Infant wide-field retinal image.
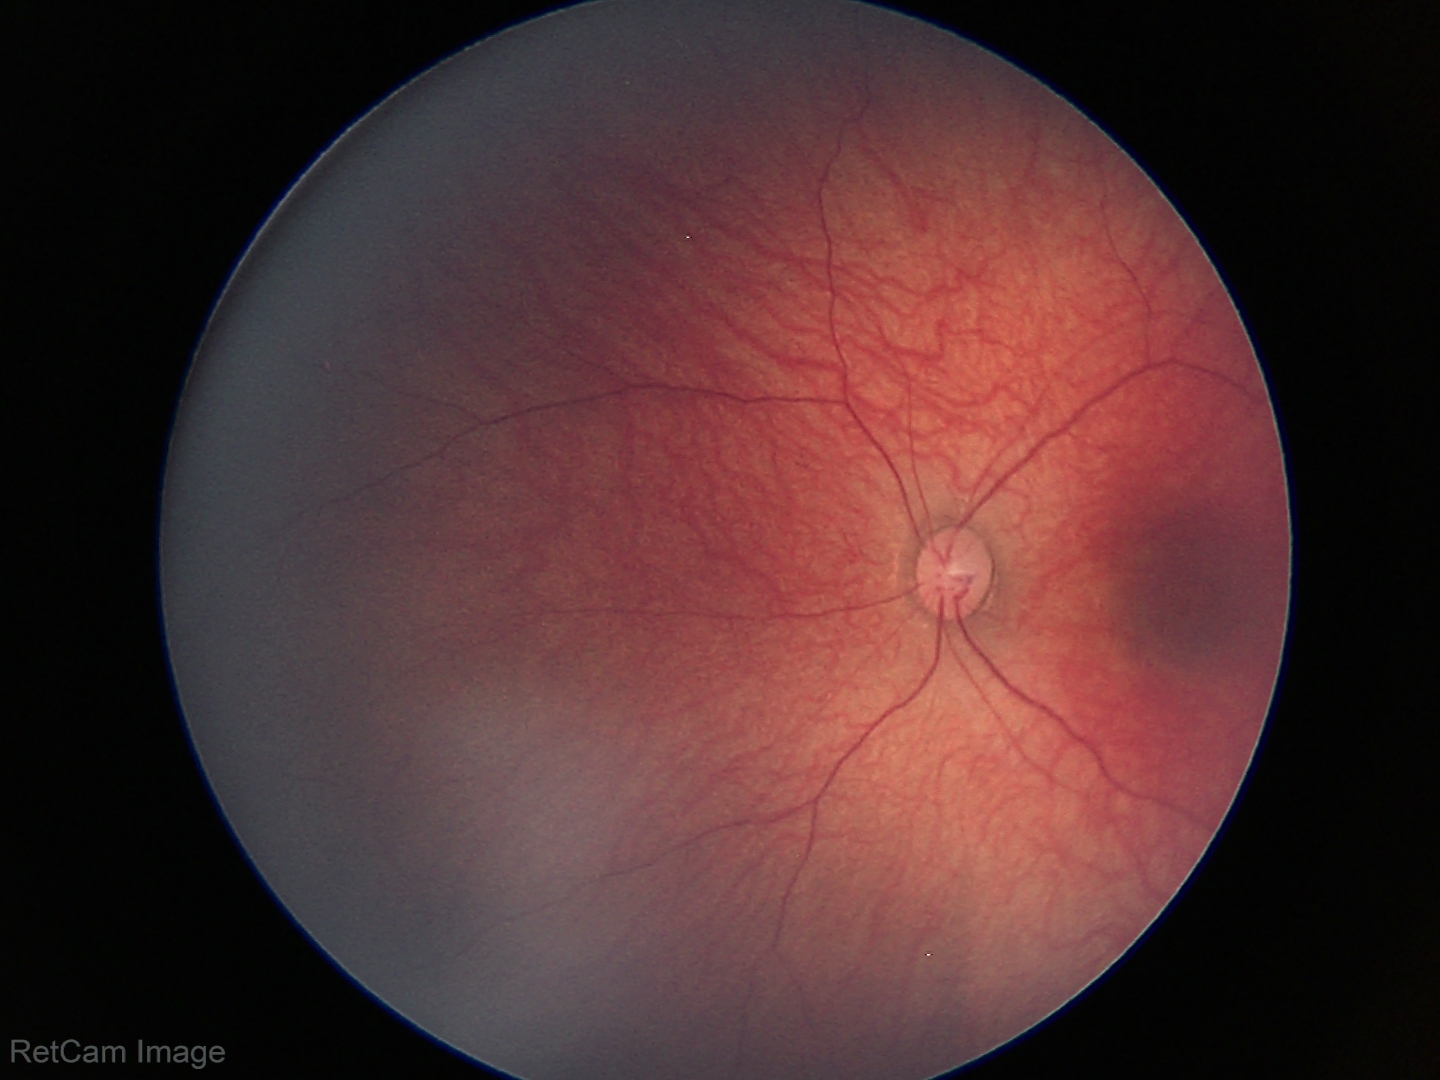

Normal screening examination.